DR severity per modified Davis staging, 45° FOV, no pharmacologic dilation, acquired with a NIDEK AFC-230, color fundus photograph
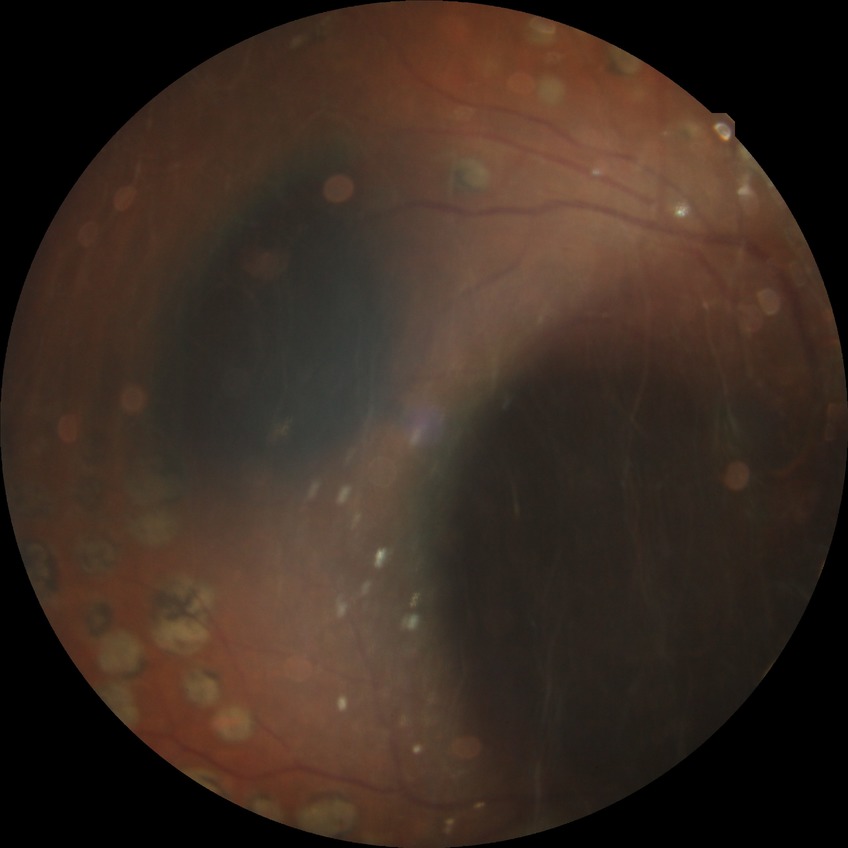

Modified Davis classification: proliferative diabetic retinopathy.